Nonmydriatic · modified Davis classification.
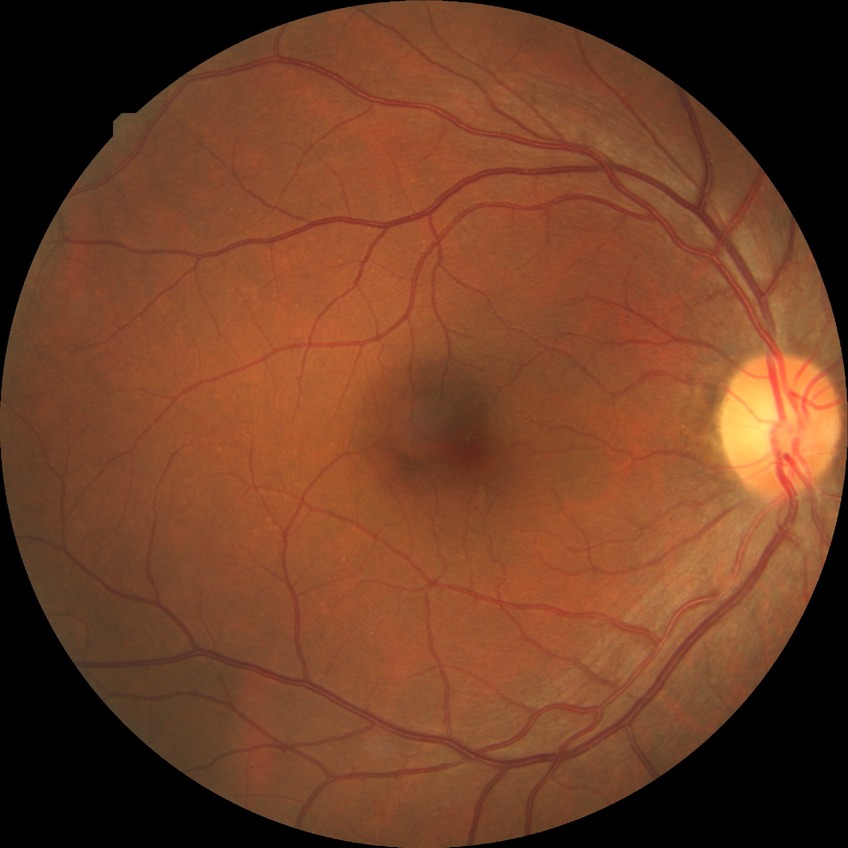 modified Davis classification: simple diabetic retinopathy.